45° field of view
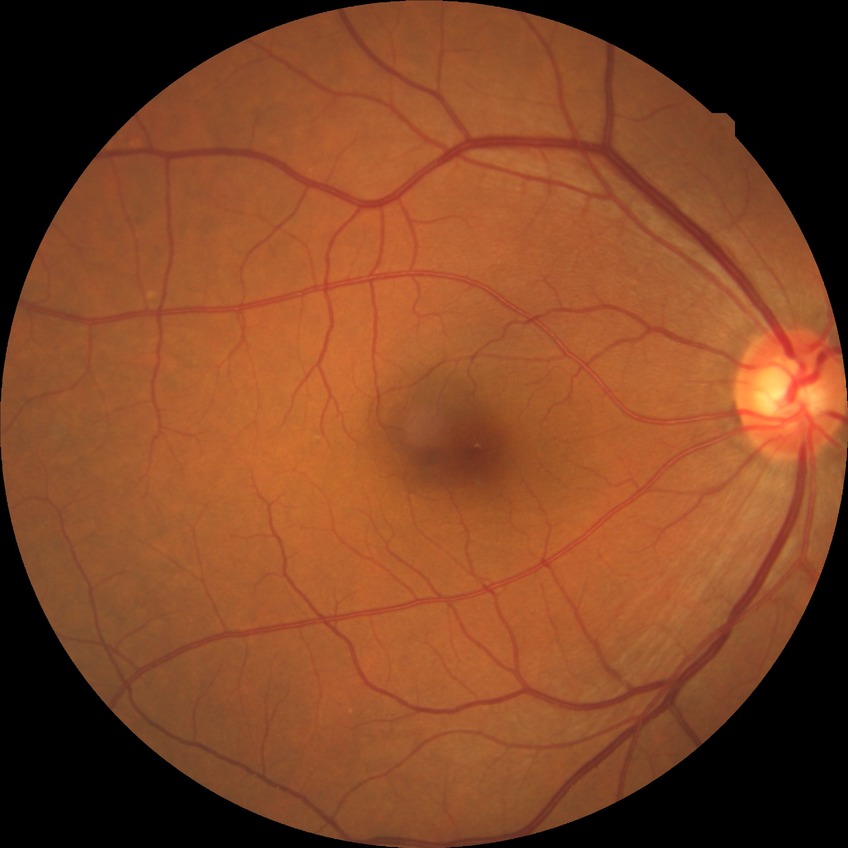
  davis_grade: NDR
  dr_impression: negative for DR